848x848px, nonmydriatic, modified Davis classification, acquired with a NIDEK AFC-230, retinal fundus photograph, 45° field of view — 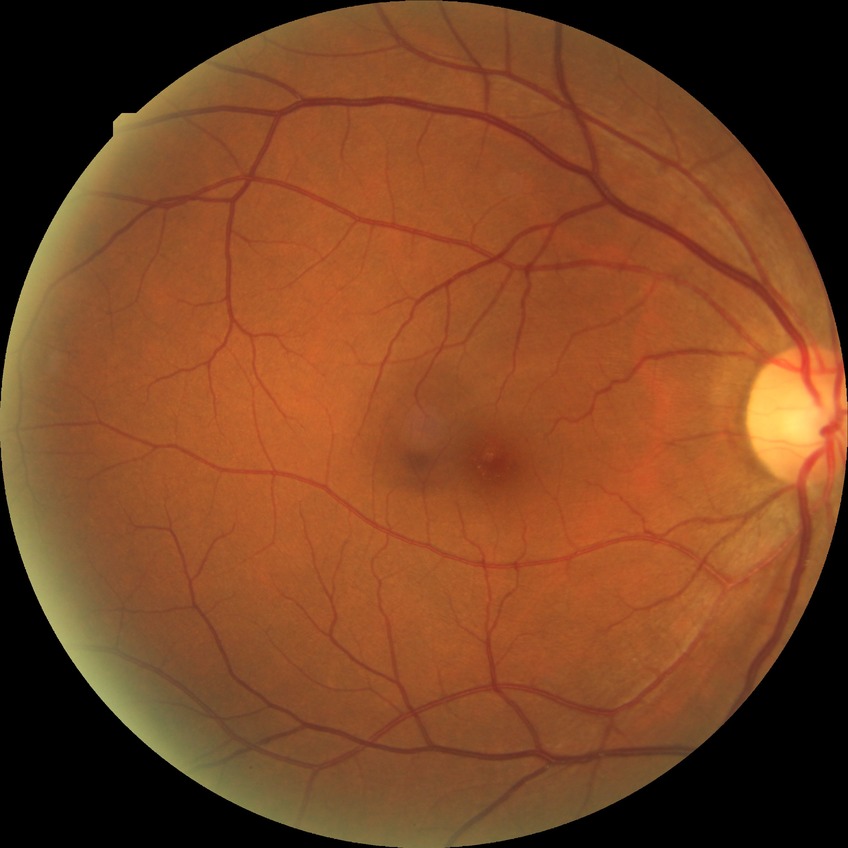 diabetic retinopathy (DR): NDR (no diabetic retinopathy).